Fundus photo · NIDEK AFC-230 · graded on the modified Davis scale — 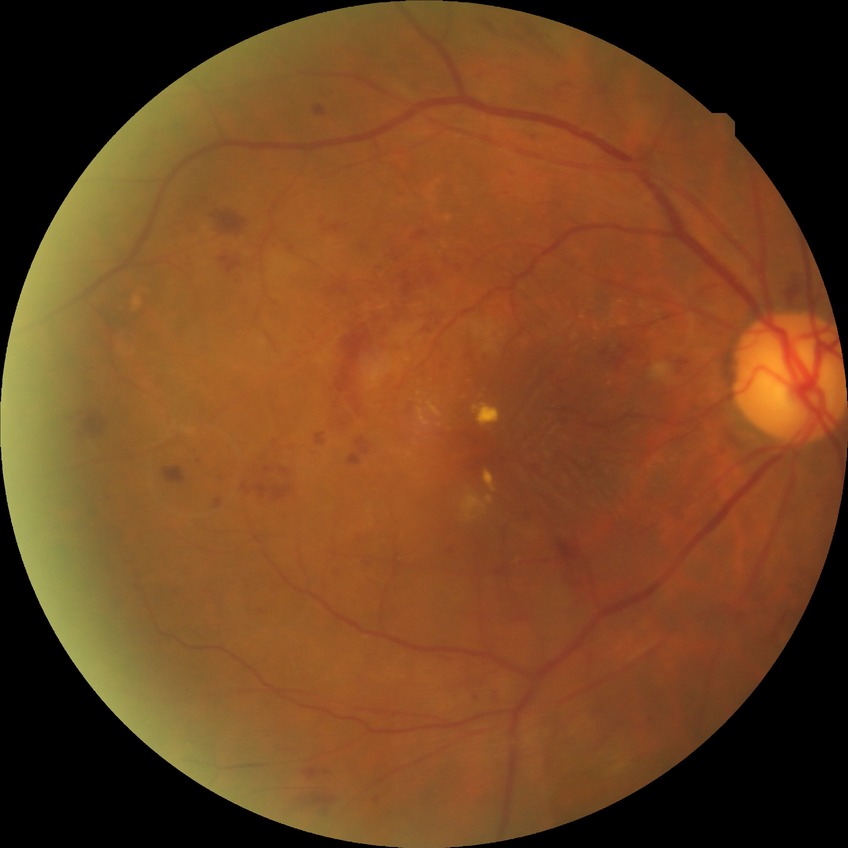 Diabetic retinopathy (DR) is PPDR (pre-proliferative diabetic retinopathy).
The retinopathy is classified as non-proliferative diabetic retinopathy.